FOV 35° before cropping · color fundus photograph centered on the optic disc.
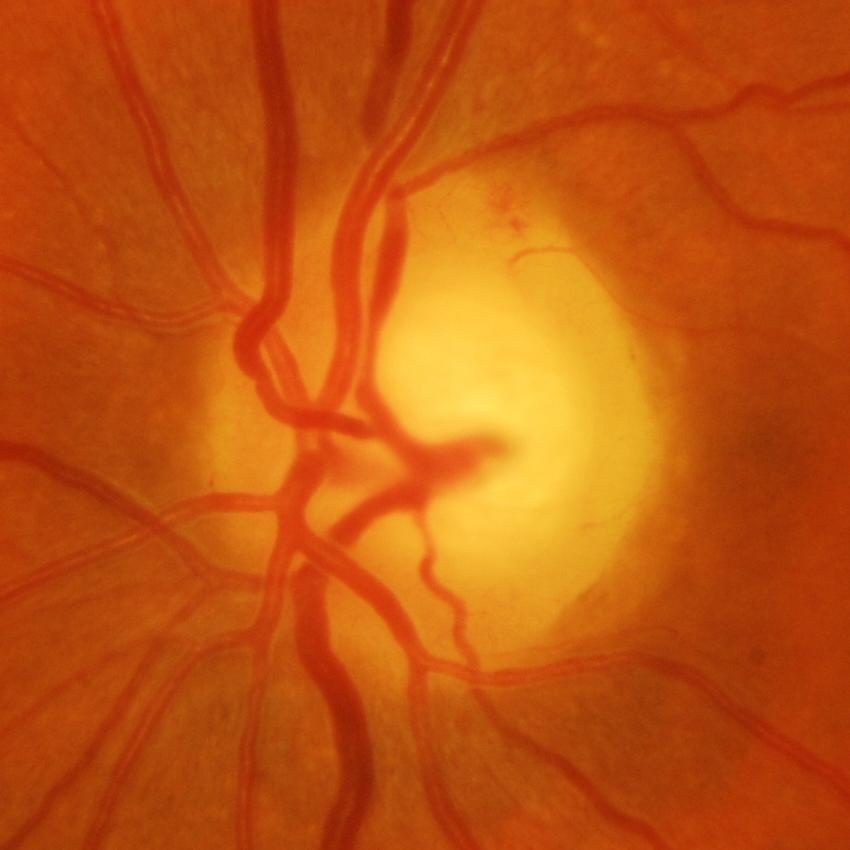 Showing glaucomatous damage to the optic nerve.